Image size 848x848: 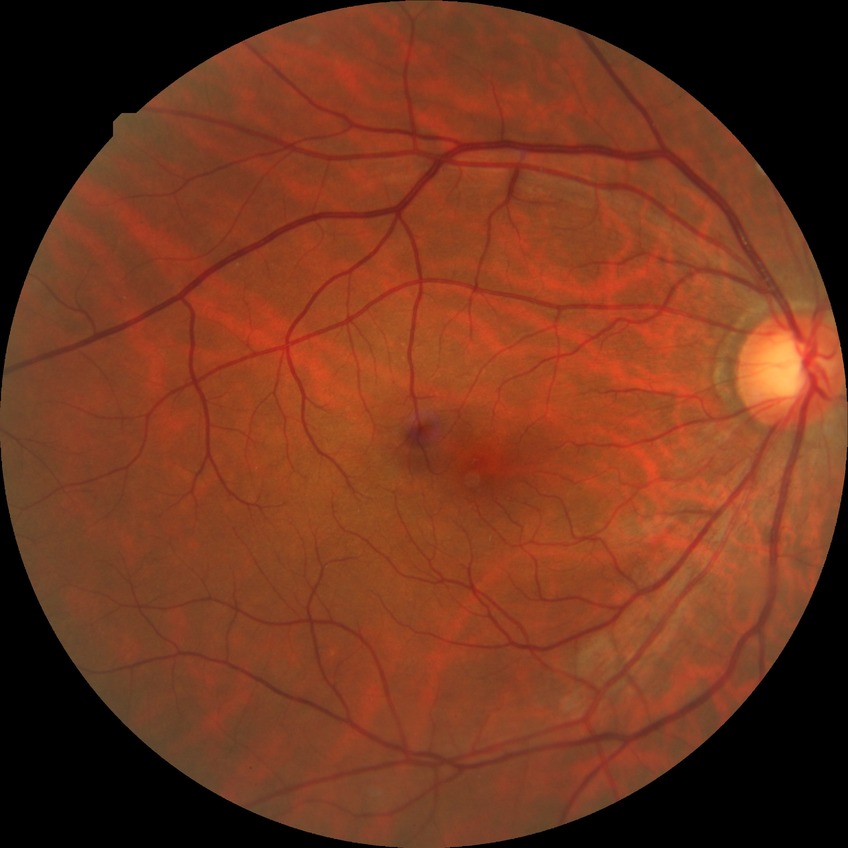

retinopathy grade: no diabetic retinopathy.